Topcon TRC-50DX:
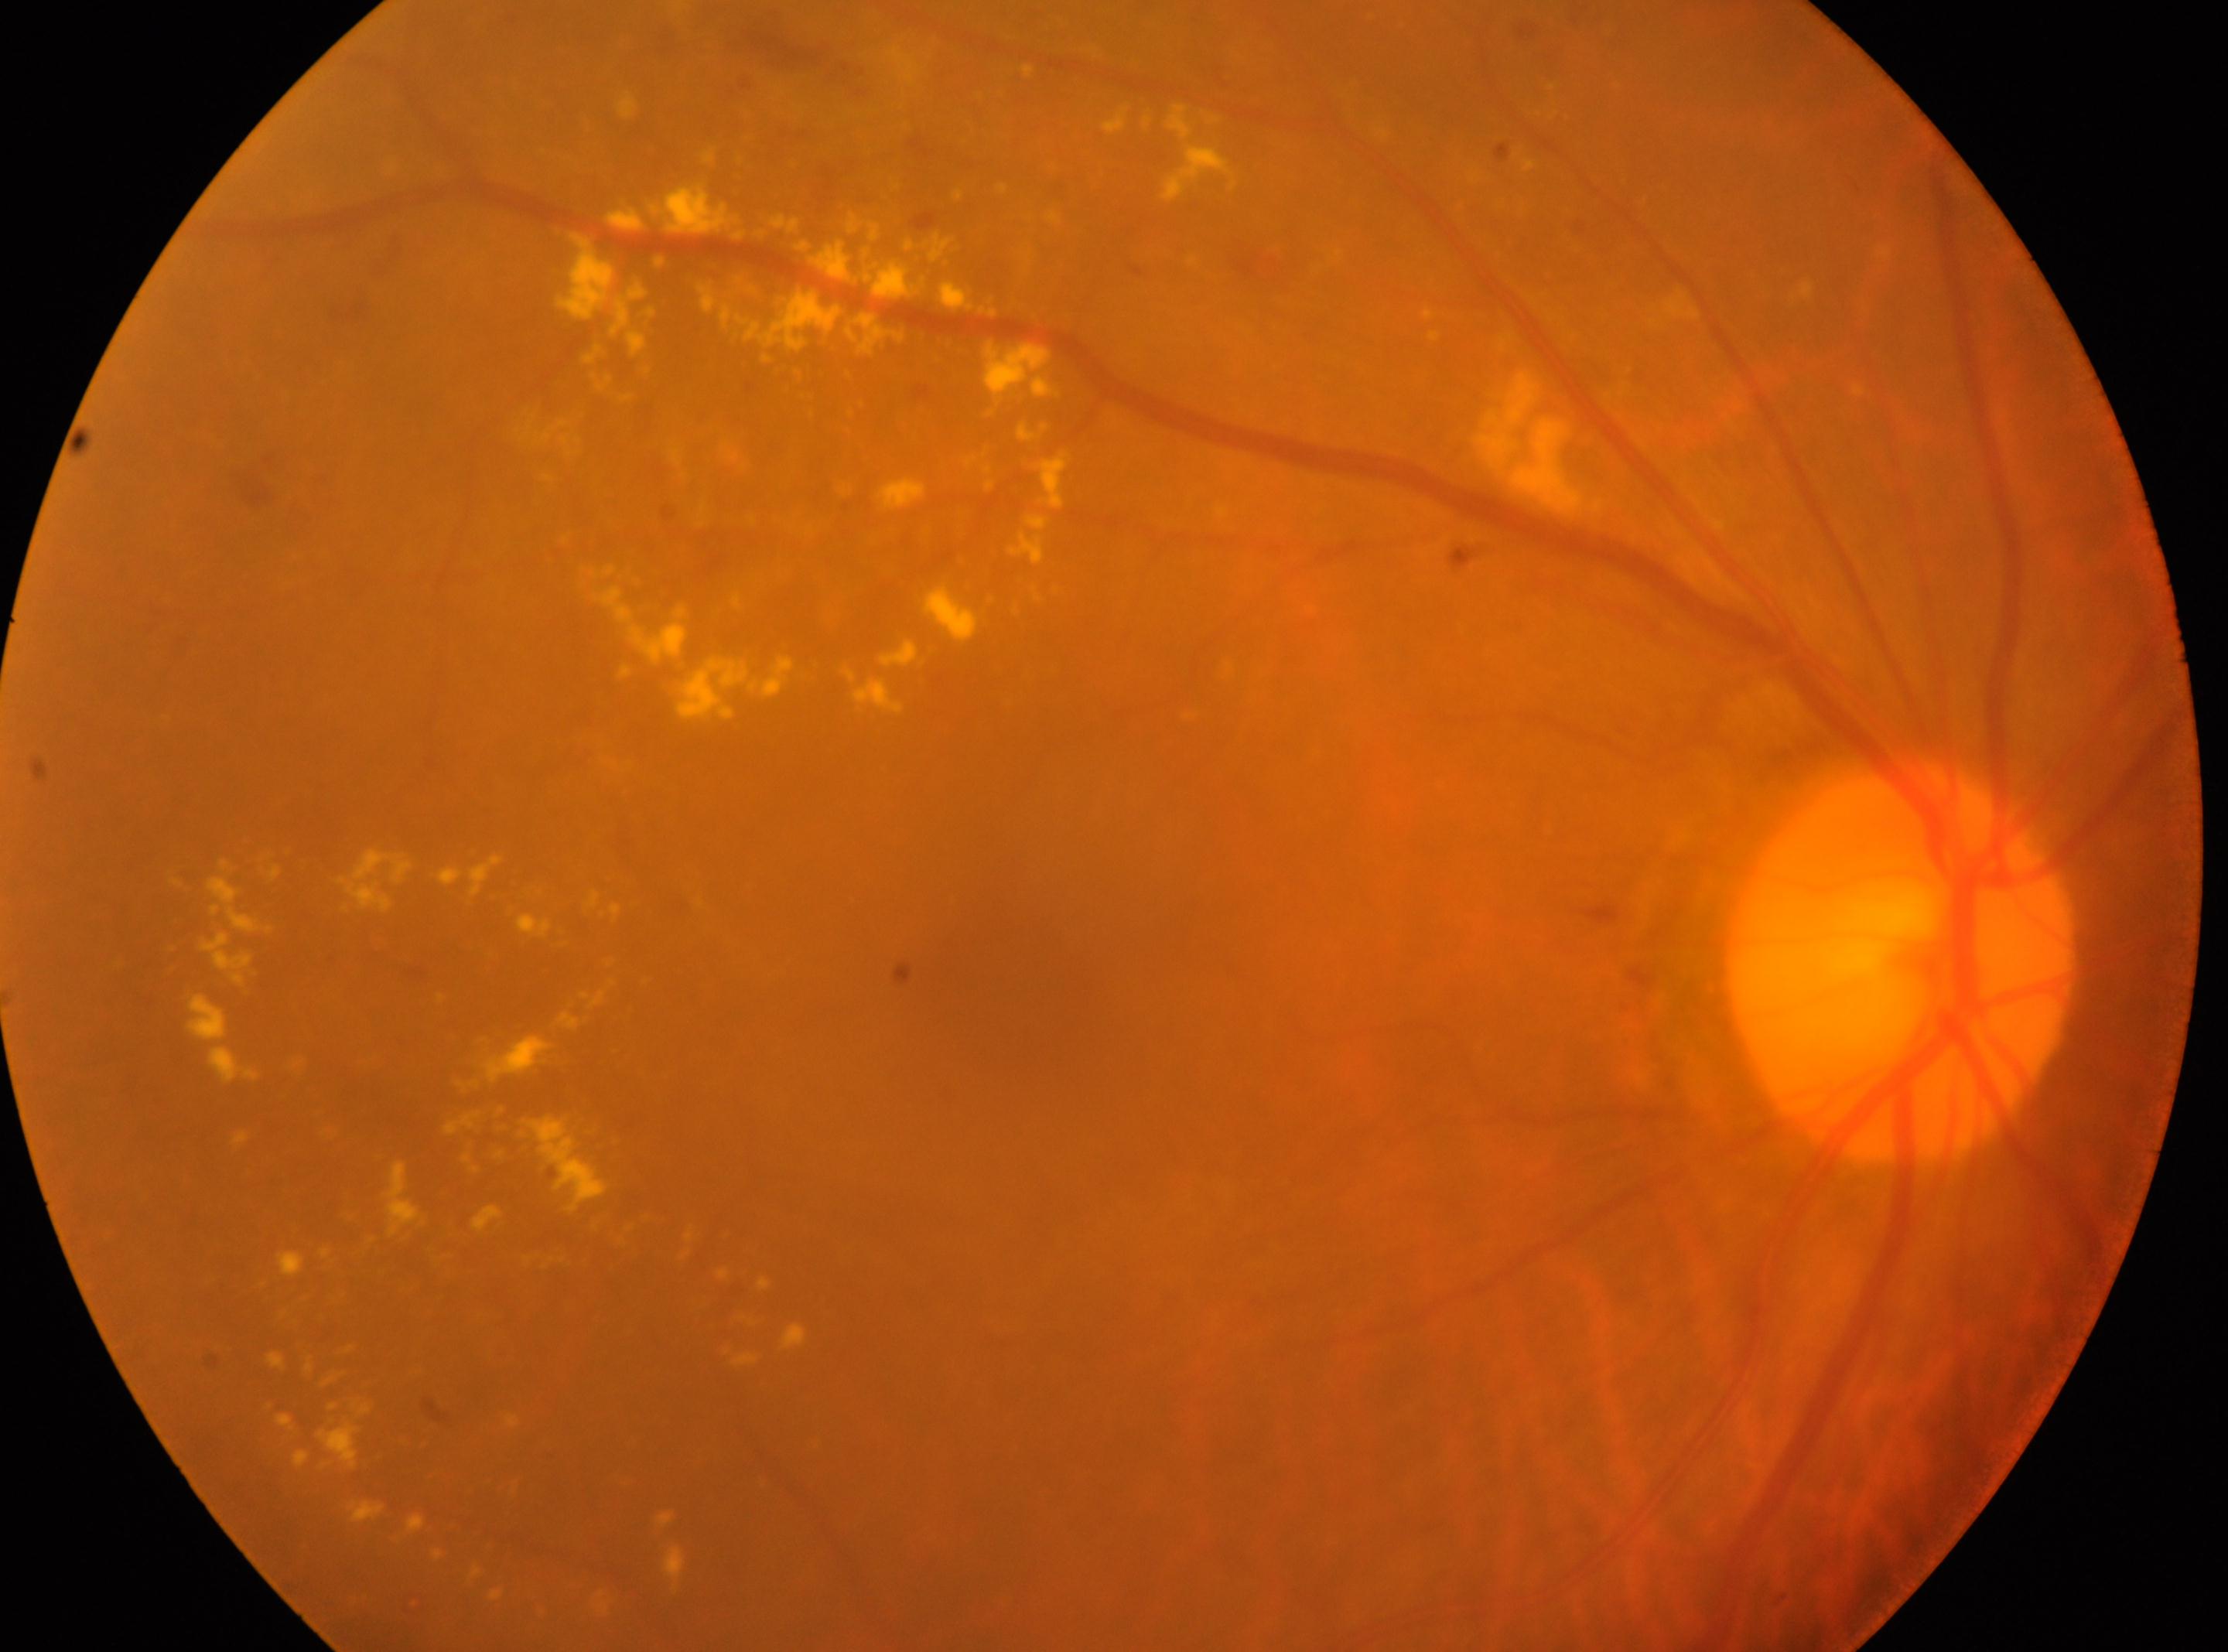 Q: Which eye is imaged?
A: the right eye
Q: Locate the optic disc.
A: 1898, 959
Q: Locate the fovea.
A: 1009, 970
Q: DR stage?
A: 2/4